Color fundus photograph · graded on the modified Davis scale:
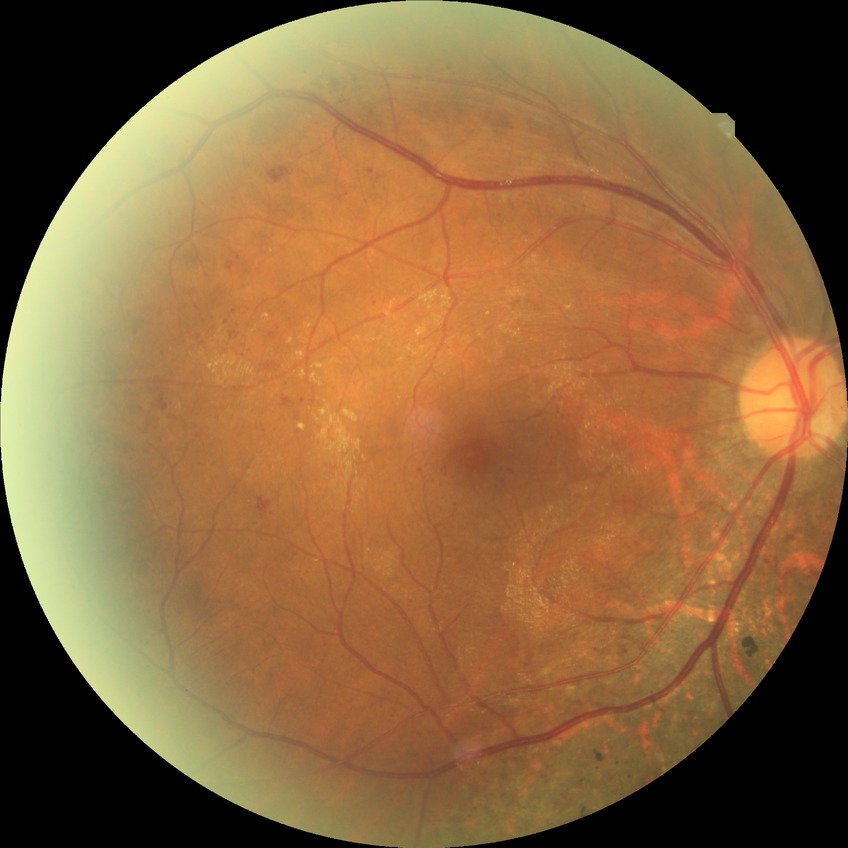 DR severity=SDR.